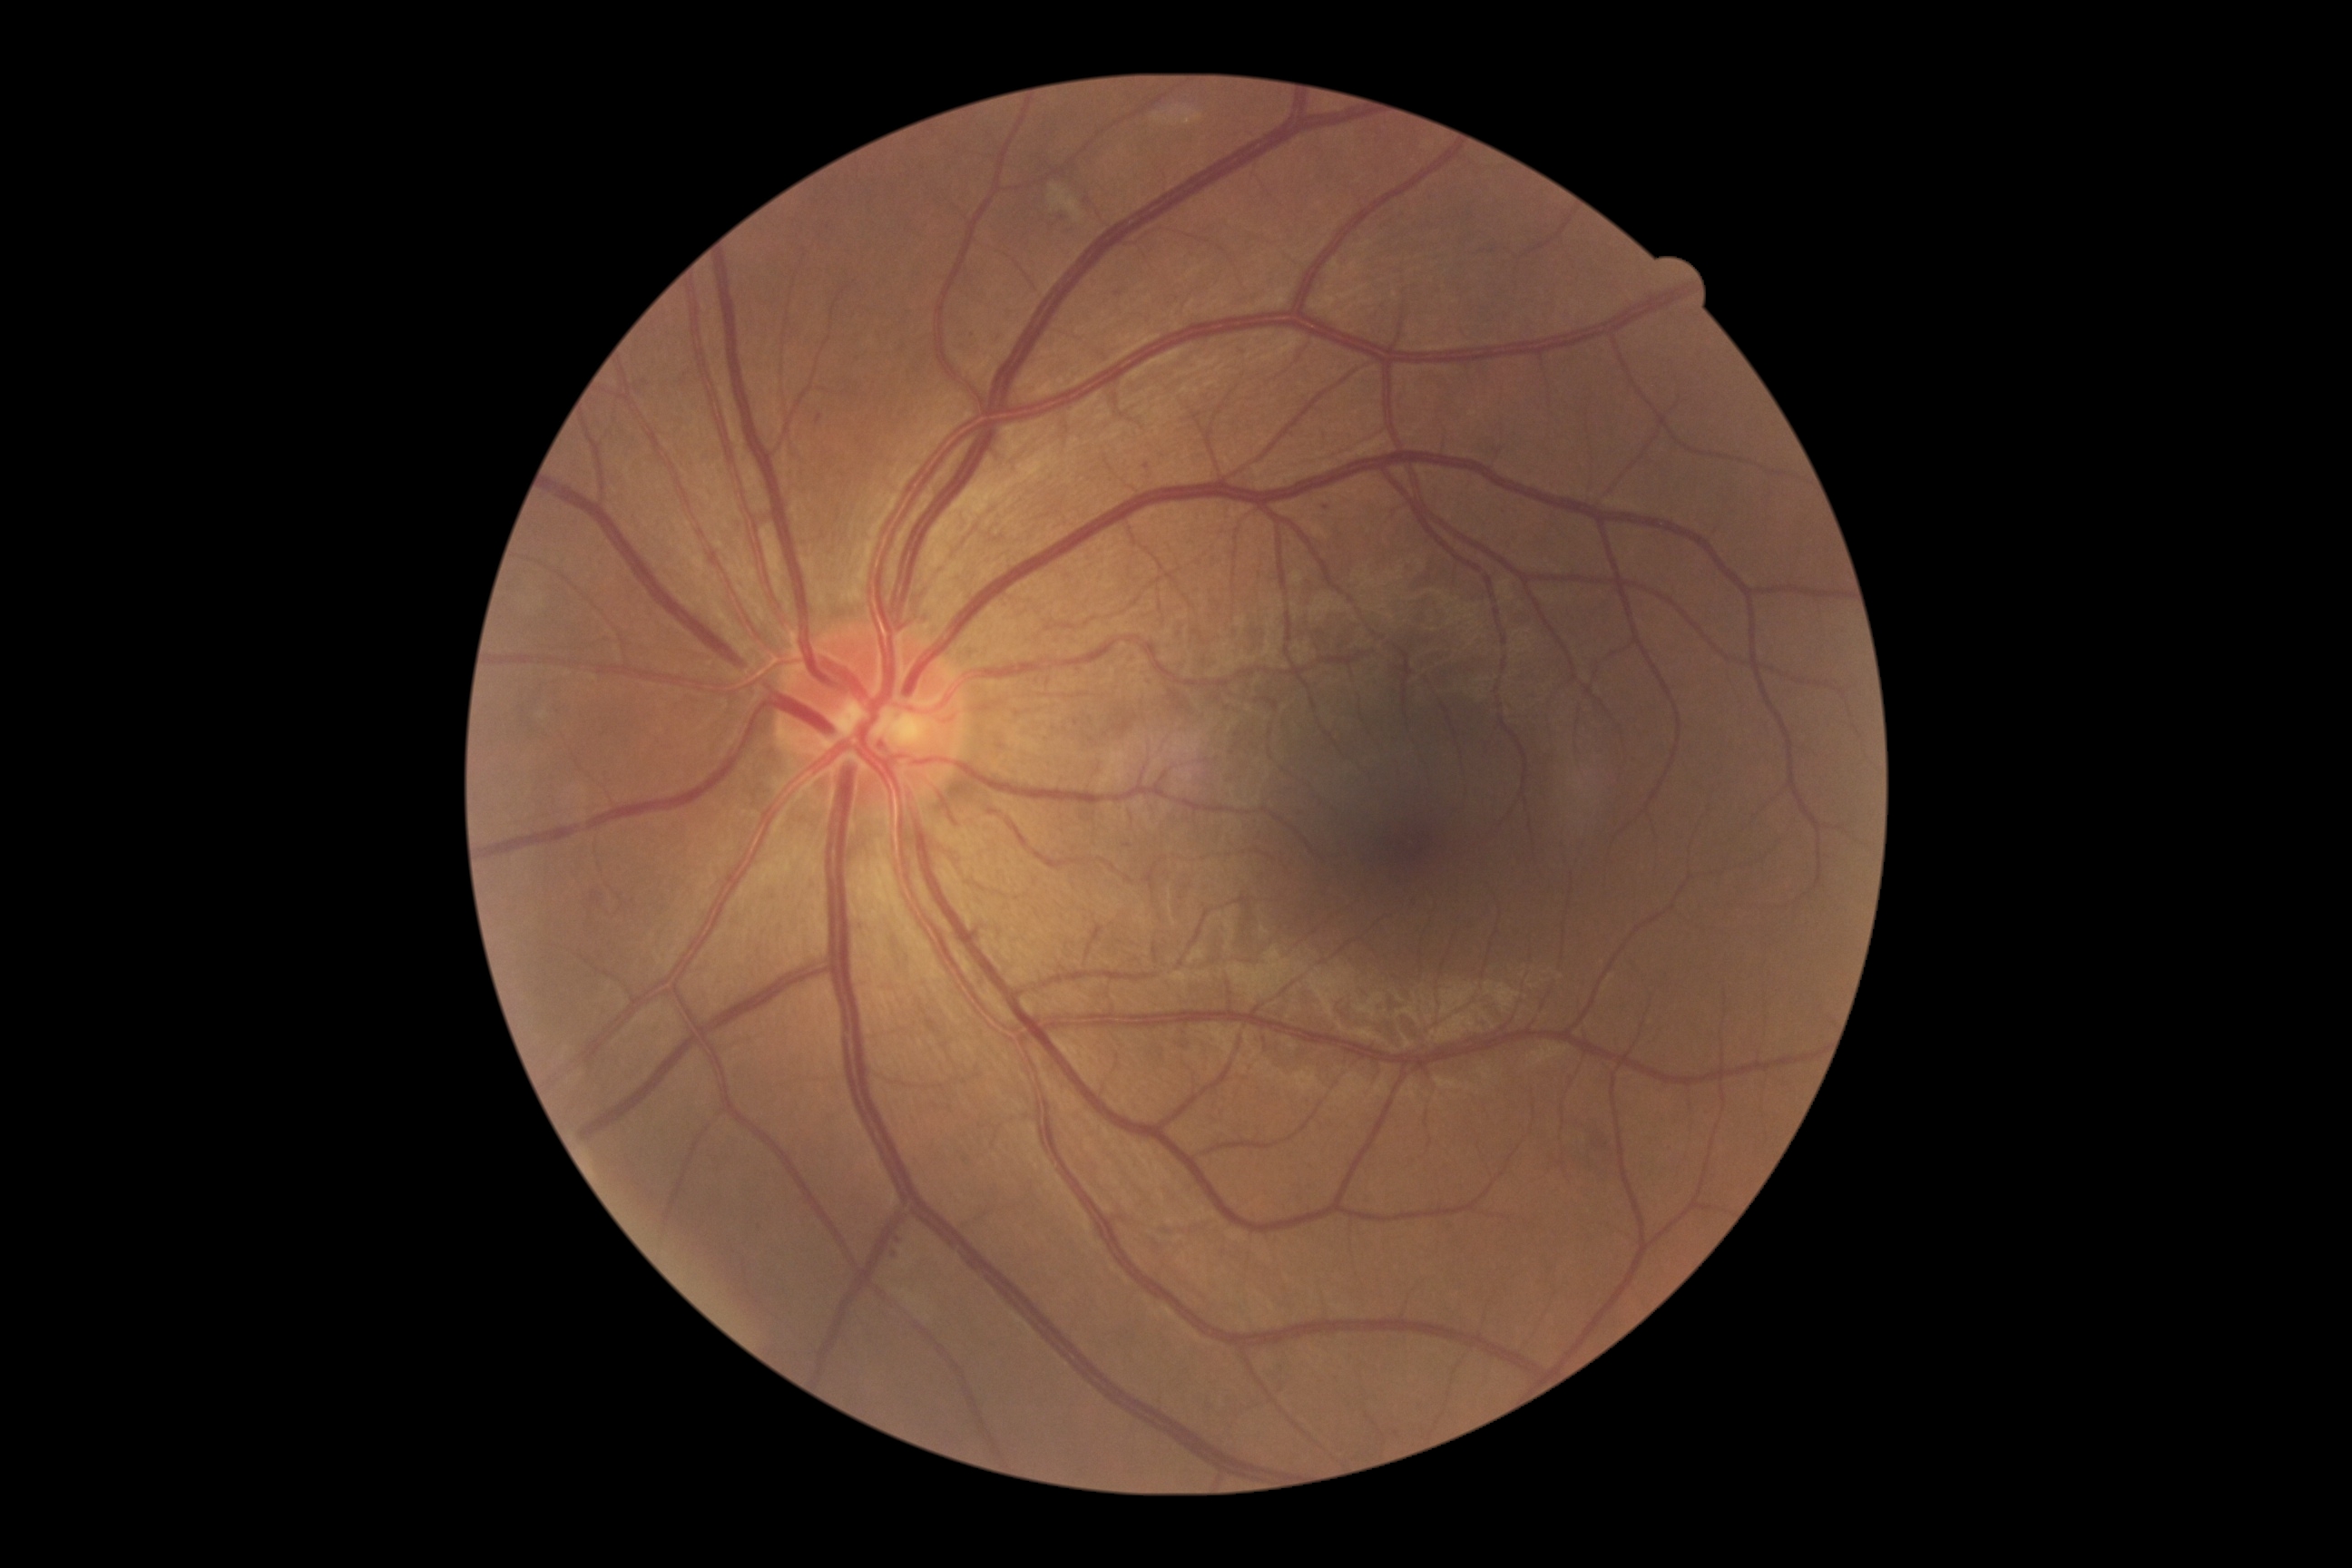

Retinopathy grade is moderate NPDR (2).